Clarity RetCam 3, 130° FOV · wide-field fundus photograph from neonatal ROP screening · 640x480:
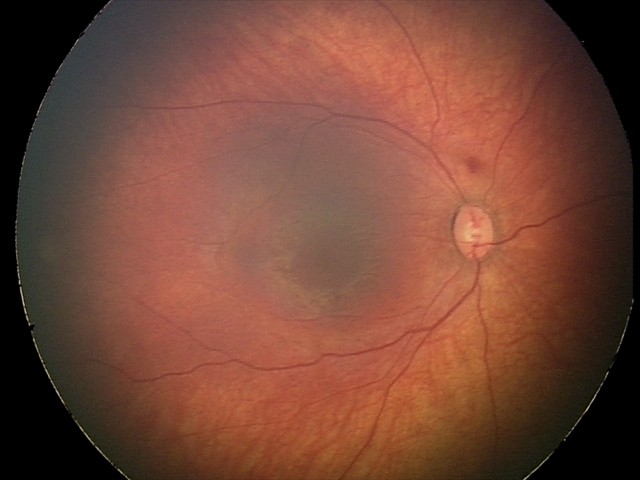

Screening series with retinal hemorrhages.